FOV: 50 degrees
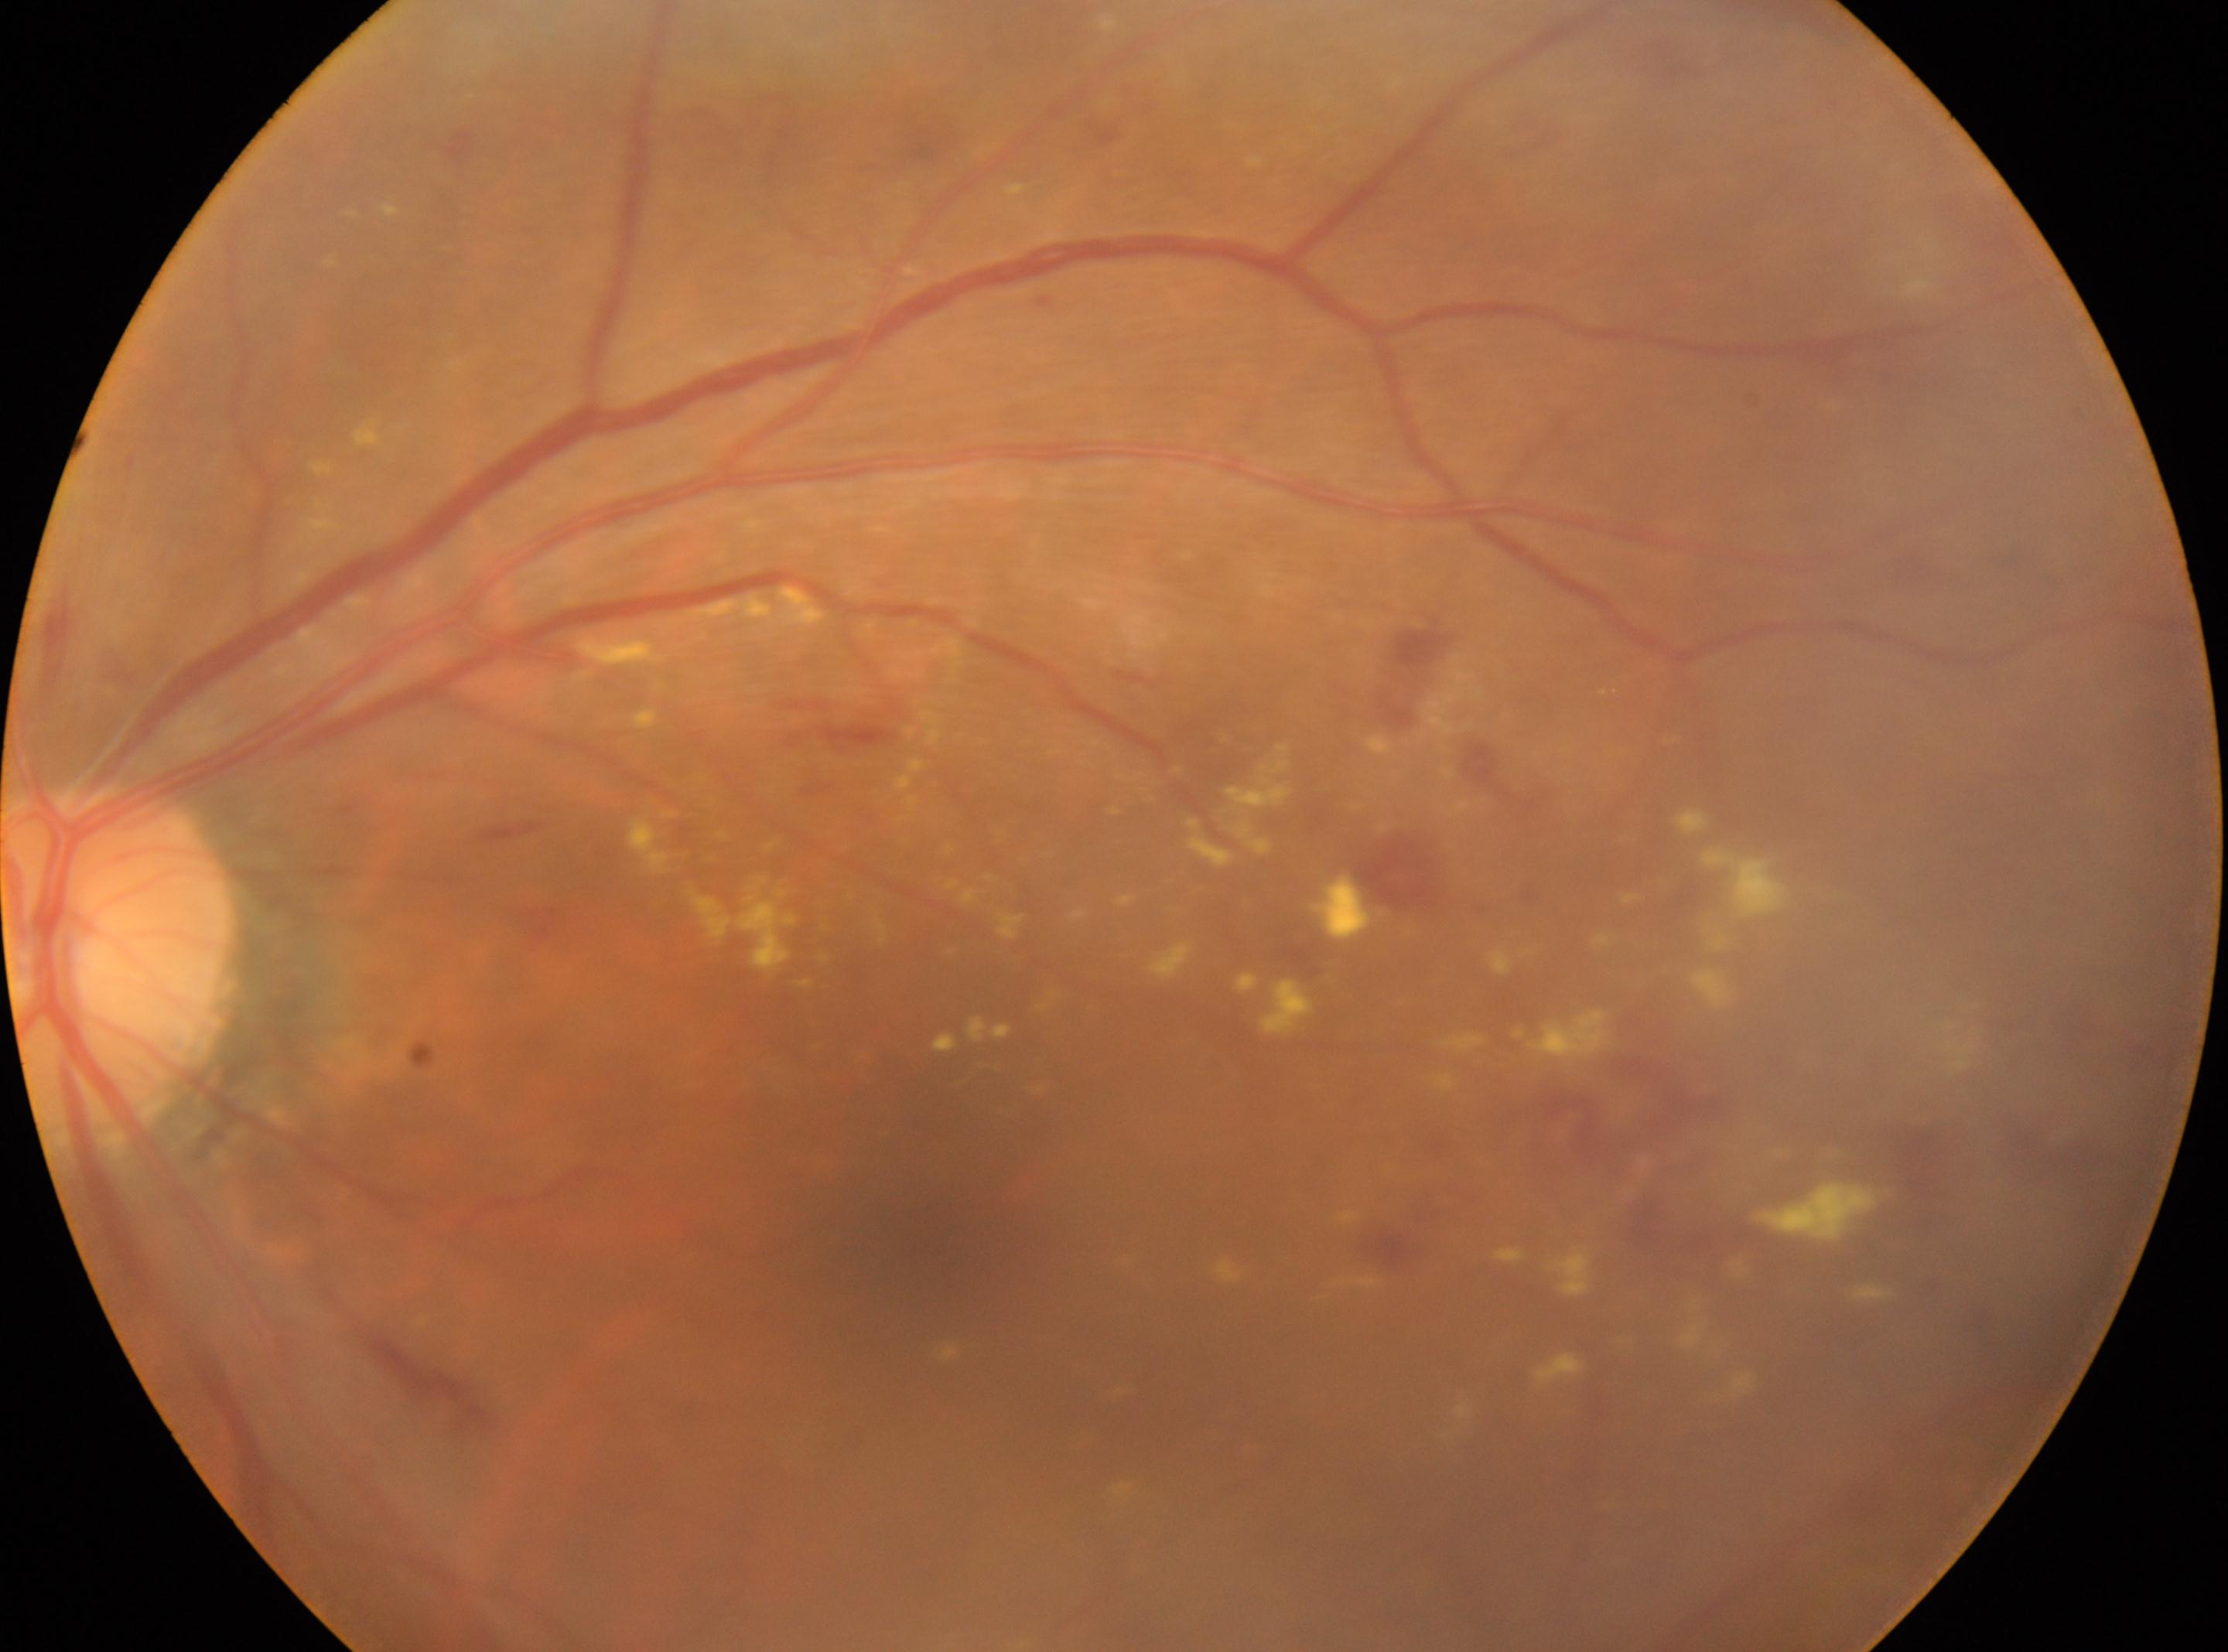 DR severity = moderate non-proliferative diabetic retinopathy (grade 2)
disc center = (117, 964)
the fovea = (911, 1241)
laterality = oculus sinister